Wide-field fundus image from infant ROP screening · 130° field of view (Natus RetCam Envision) · 1440 by 1080 pixels:
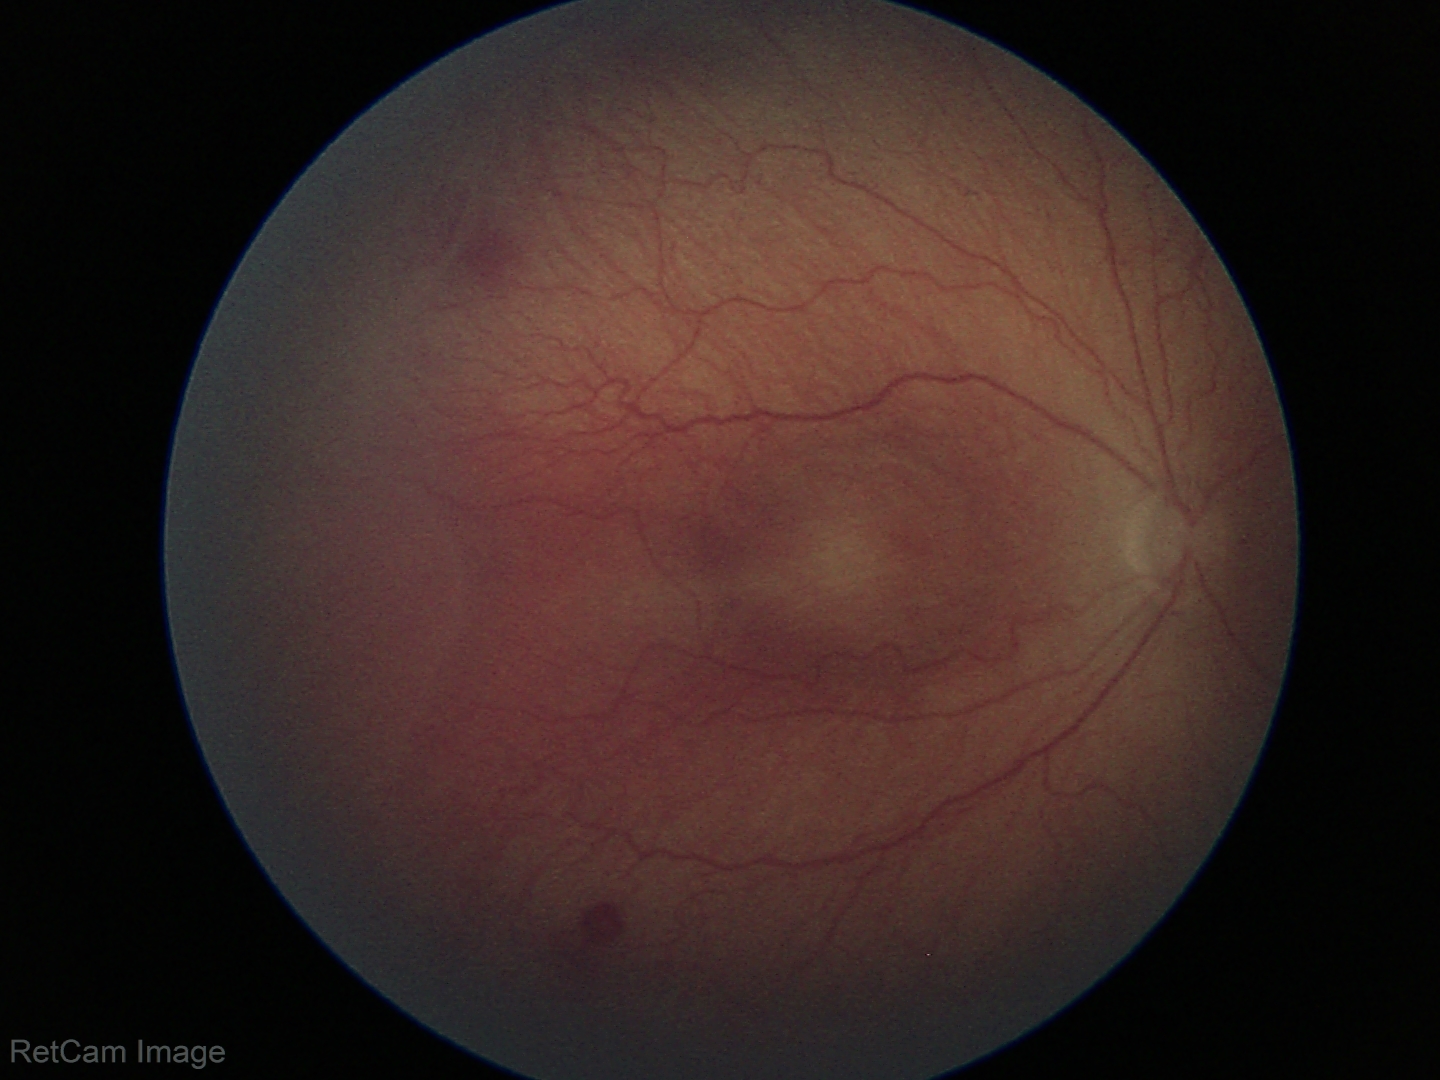

Screening diagnosis: retinopathy of prematurity stage 2.